45° FOV
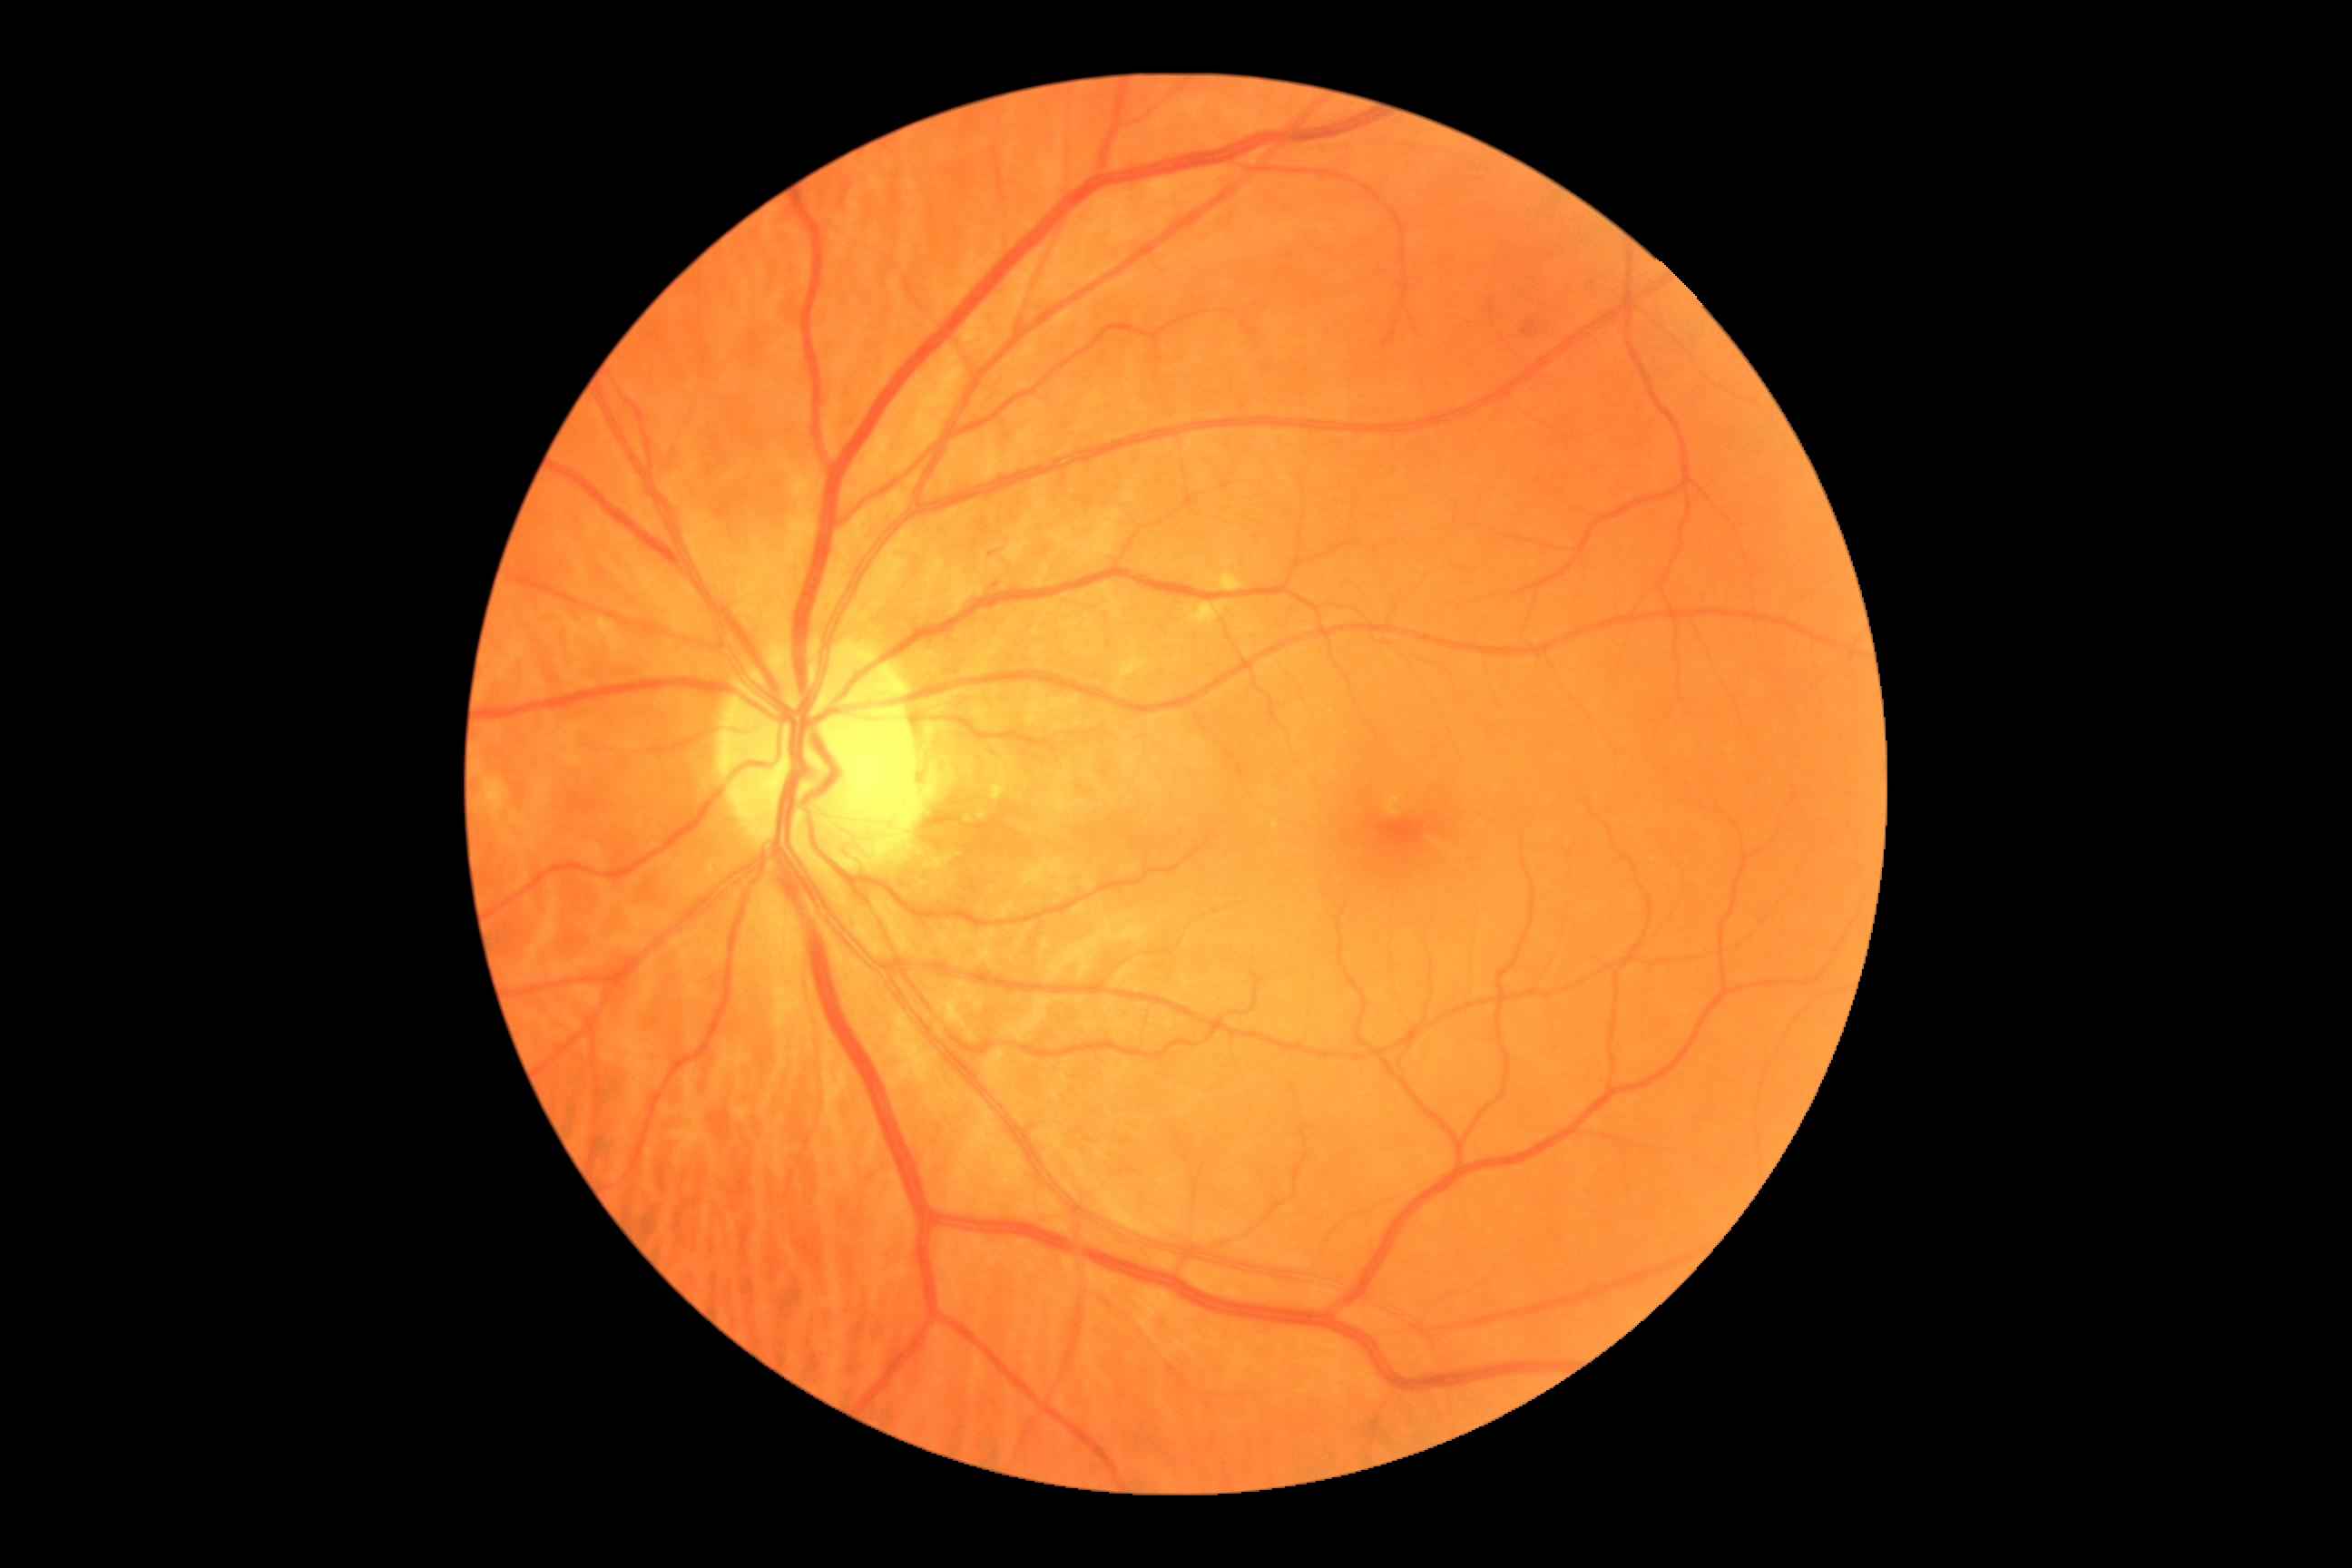 DR is 2/4 — more than just microaneurysms but less than severe NPDR.